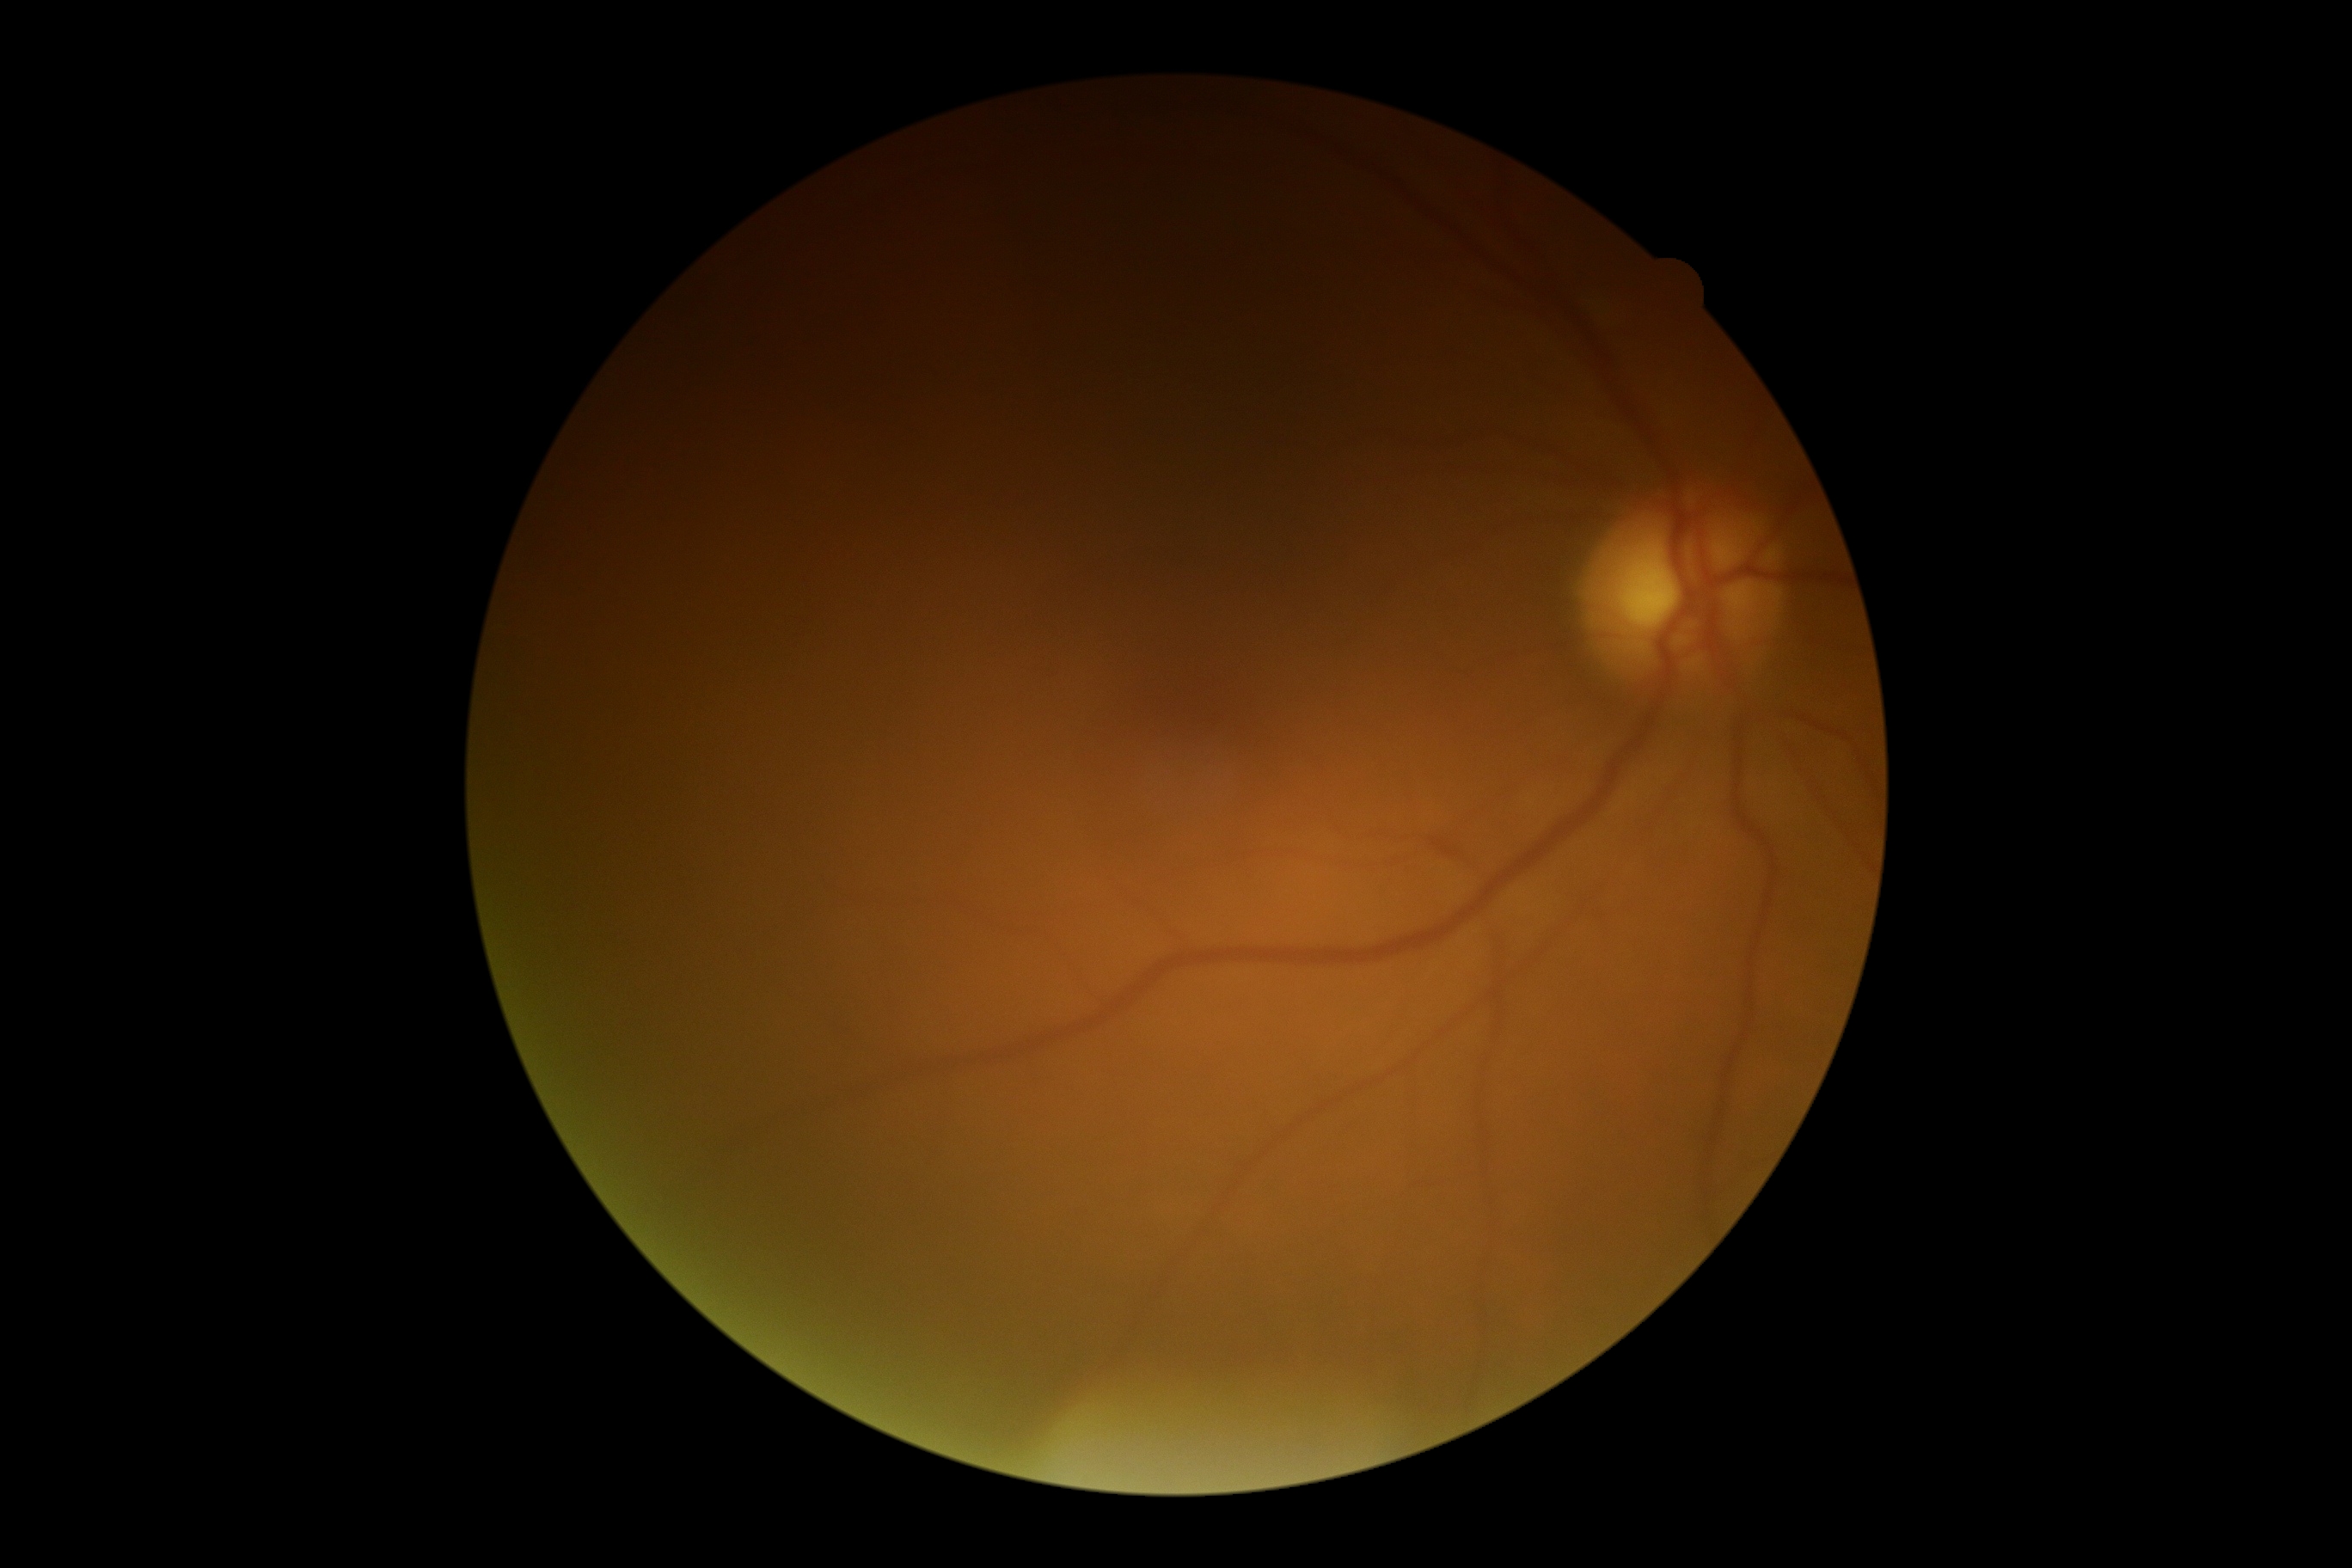 DR impression=no apparent DR, DR stage=0/4.